Ultra-widefield fundus photograph.
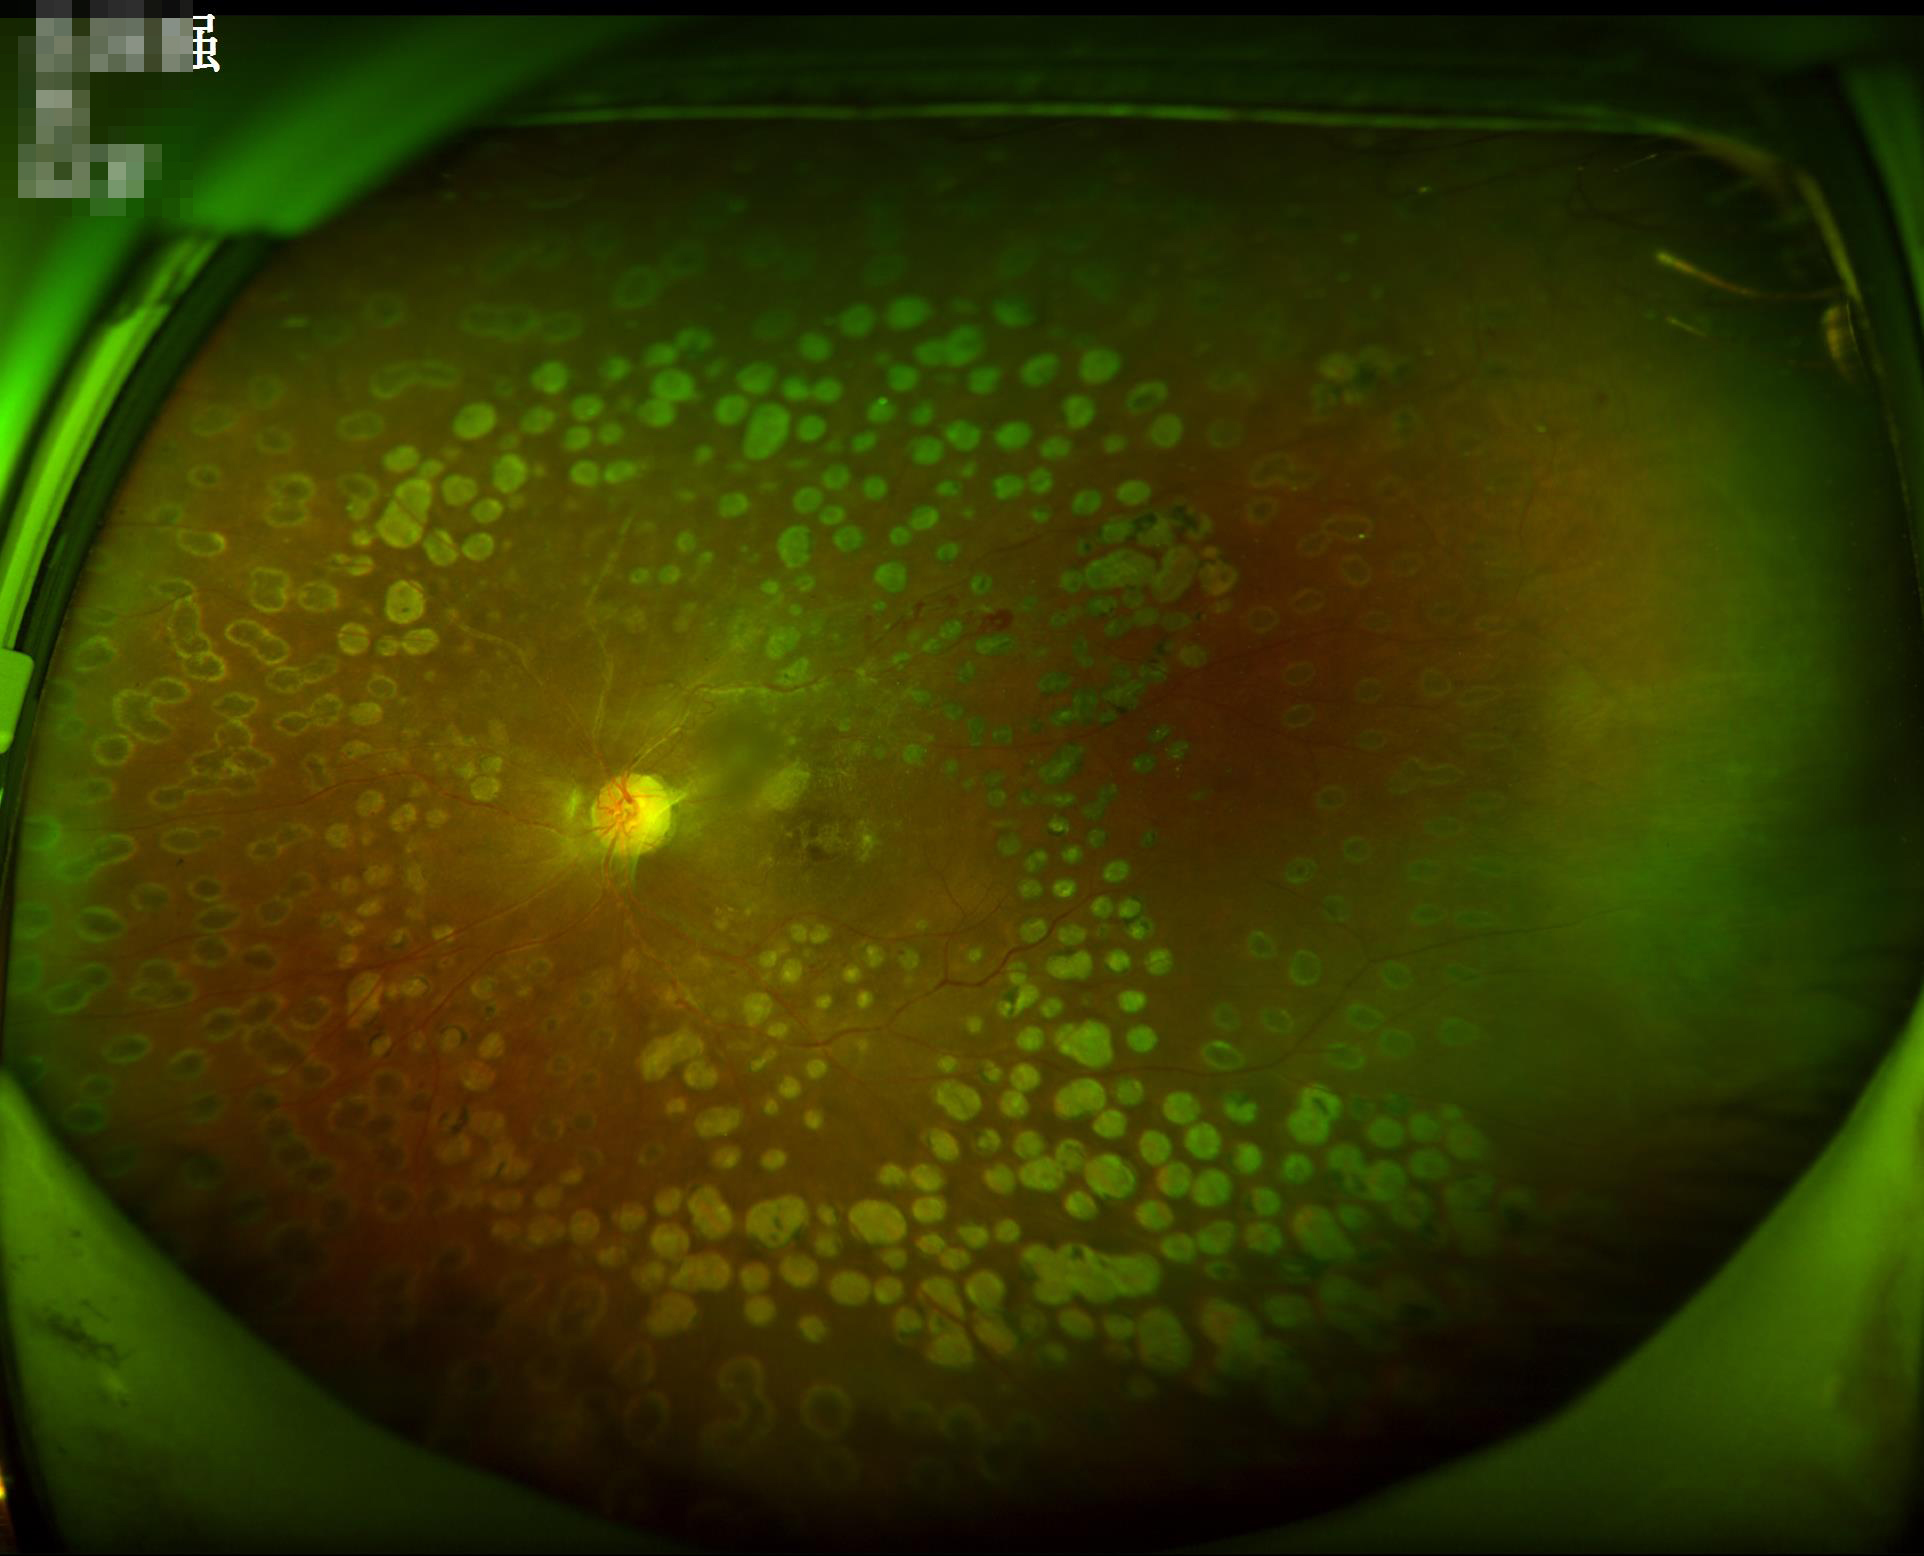
Image quality: contrast: low, vessels and details hard to distinguish; sharpness: reduced sharpness with visible blur; overall: poor, ungradable.